45° FOV. Fundus photo.
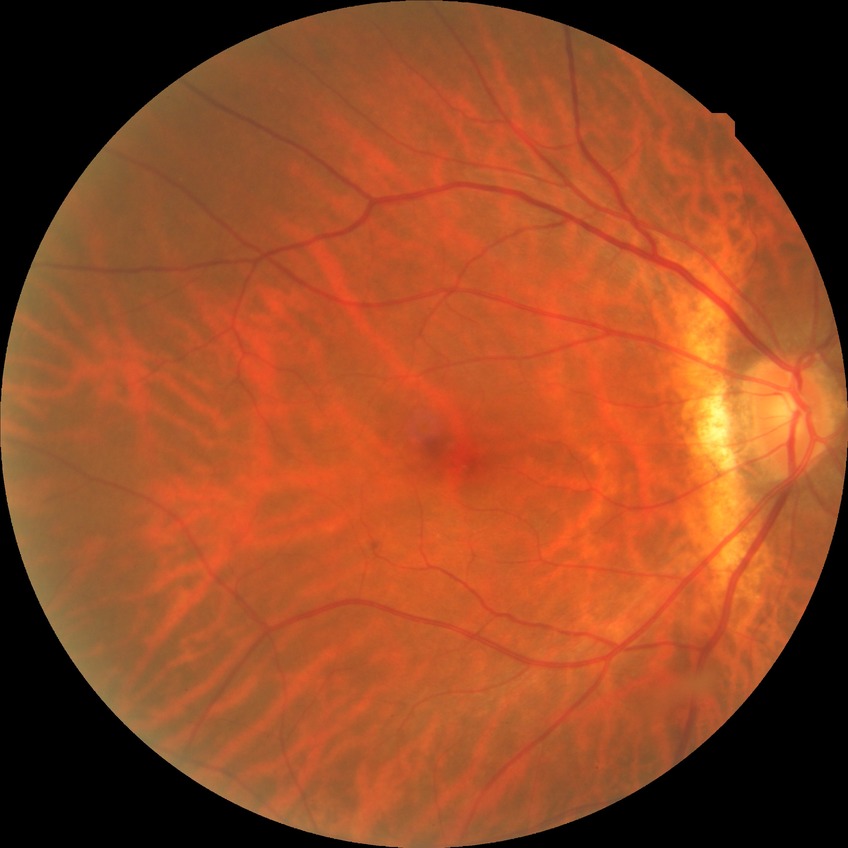 diabetic retinopathy grade: no diabetic retinopathy